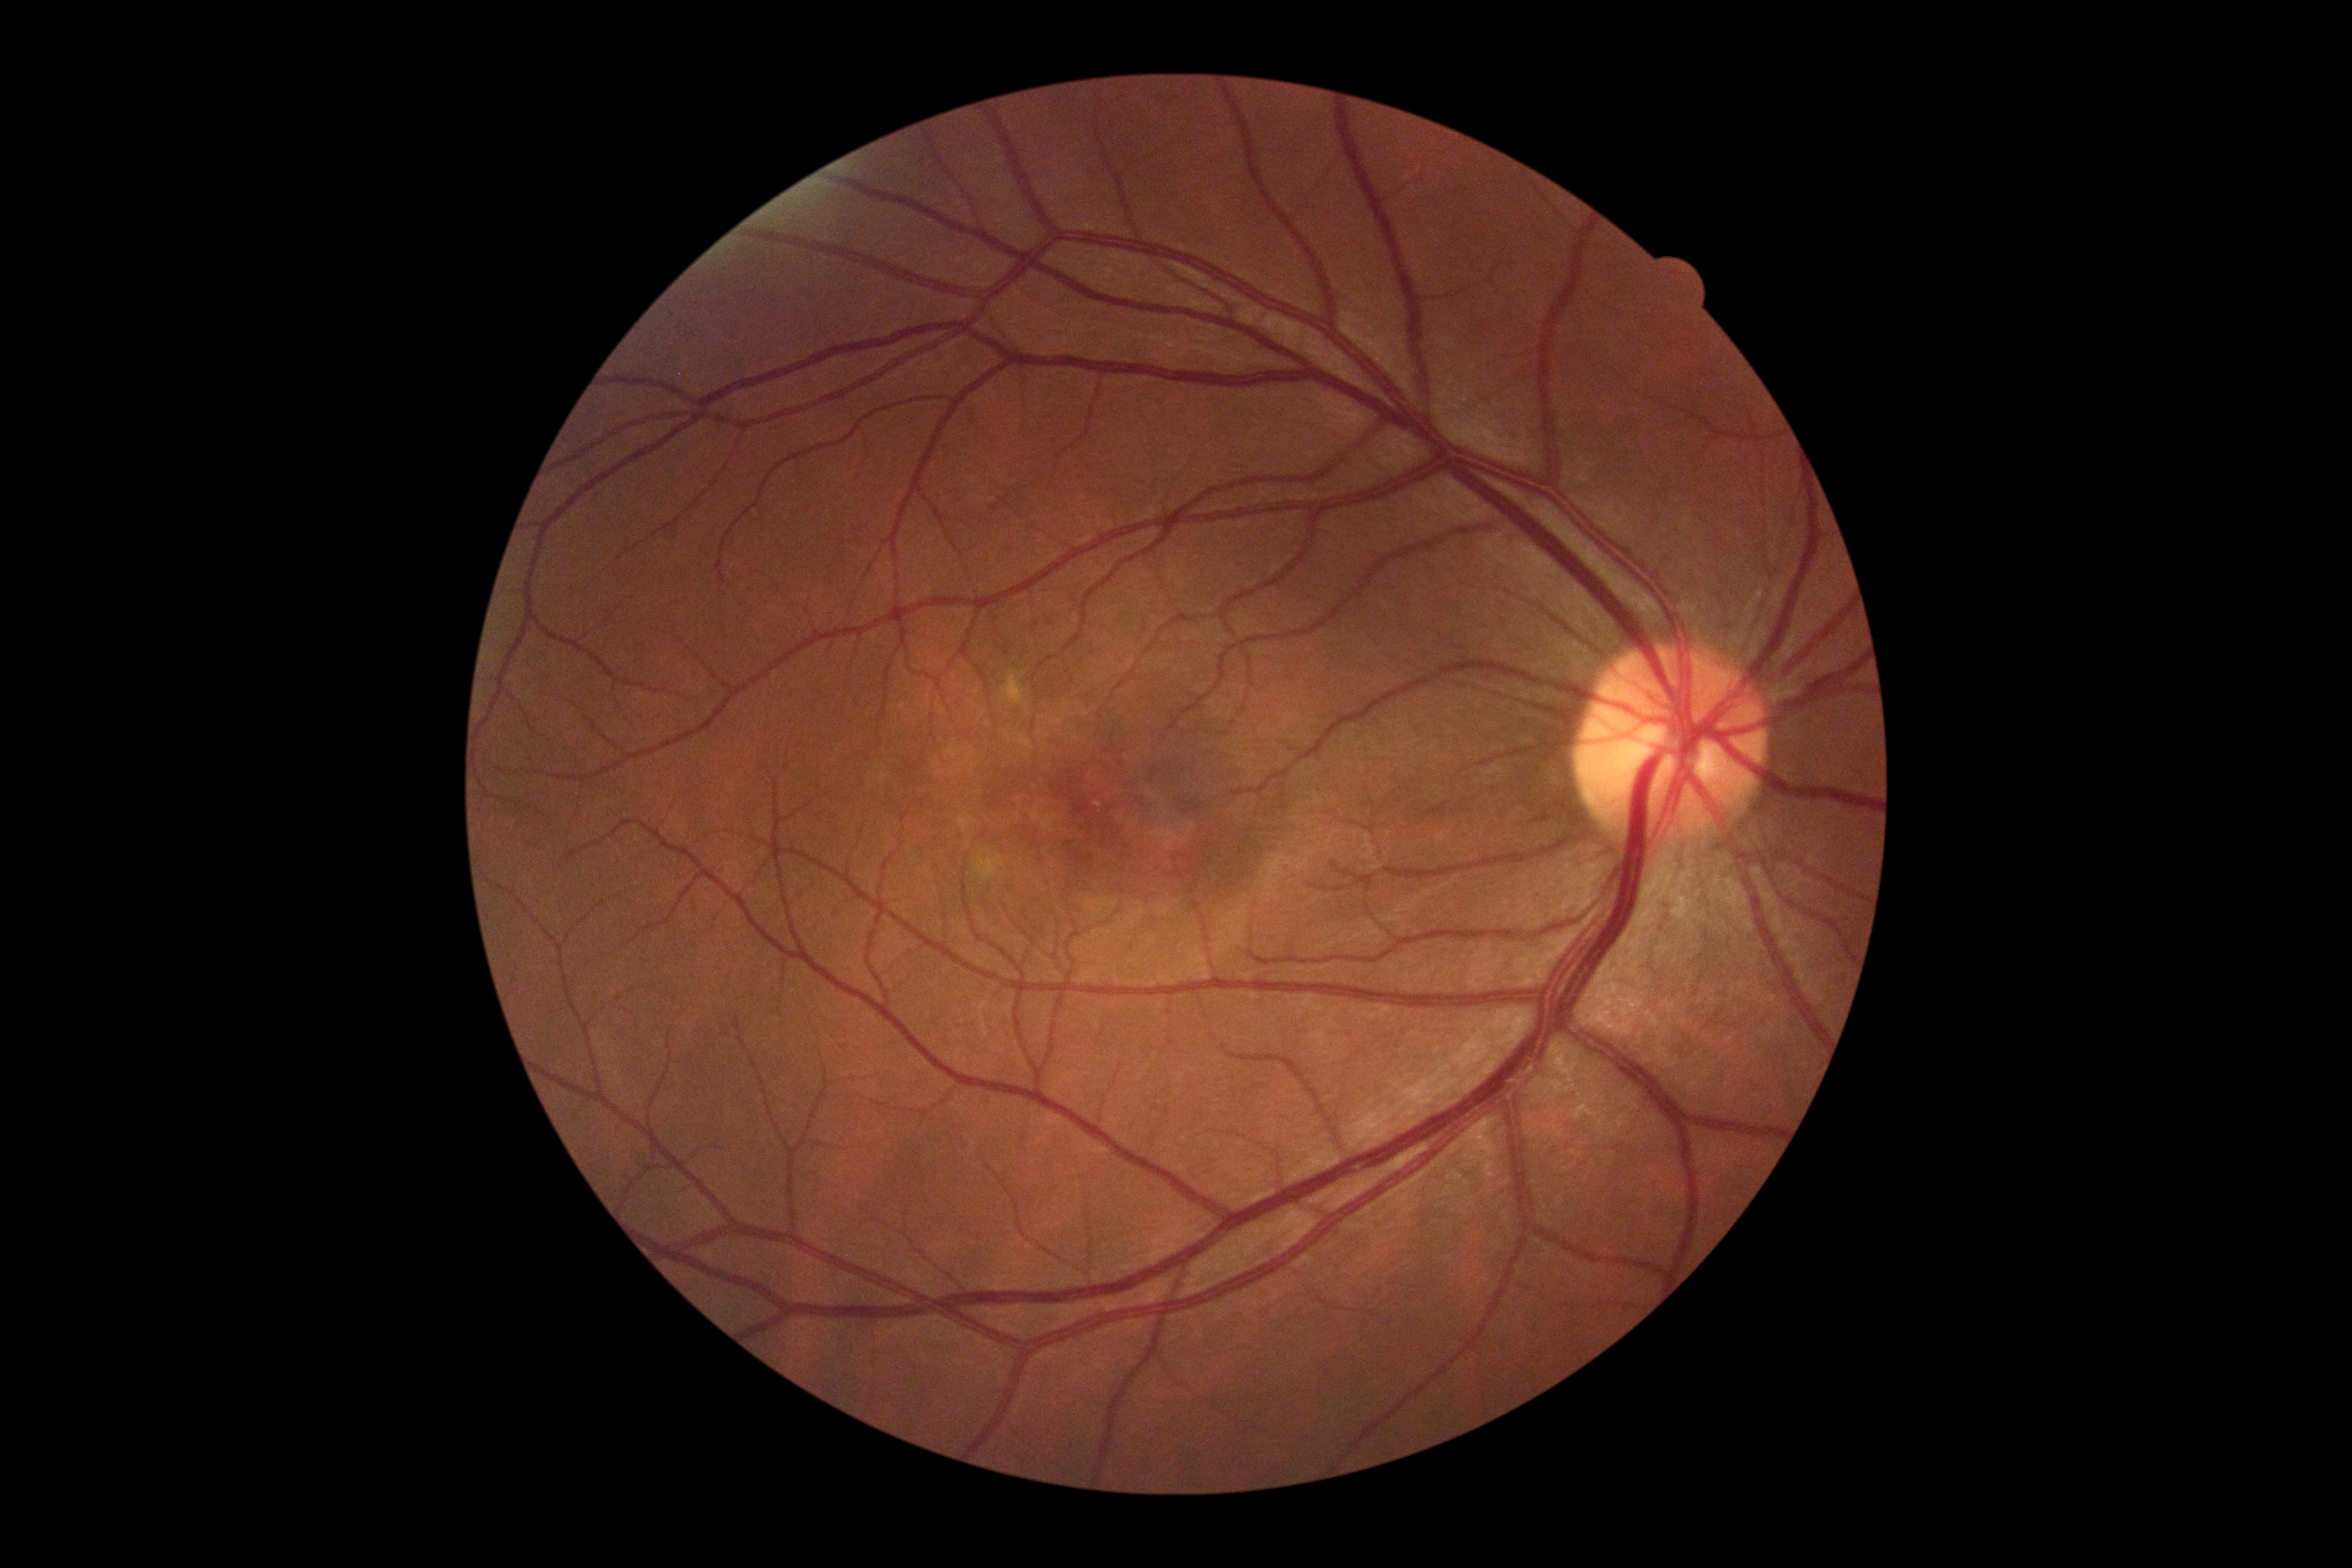 DR: grade 0 (no apparent retinopathy).